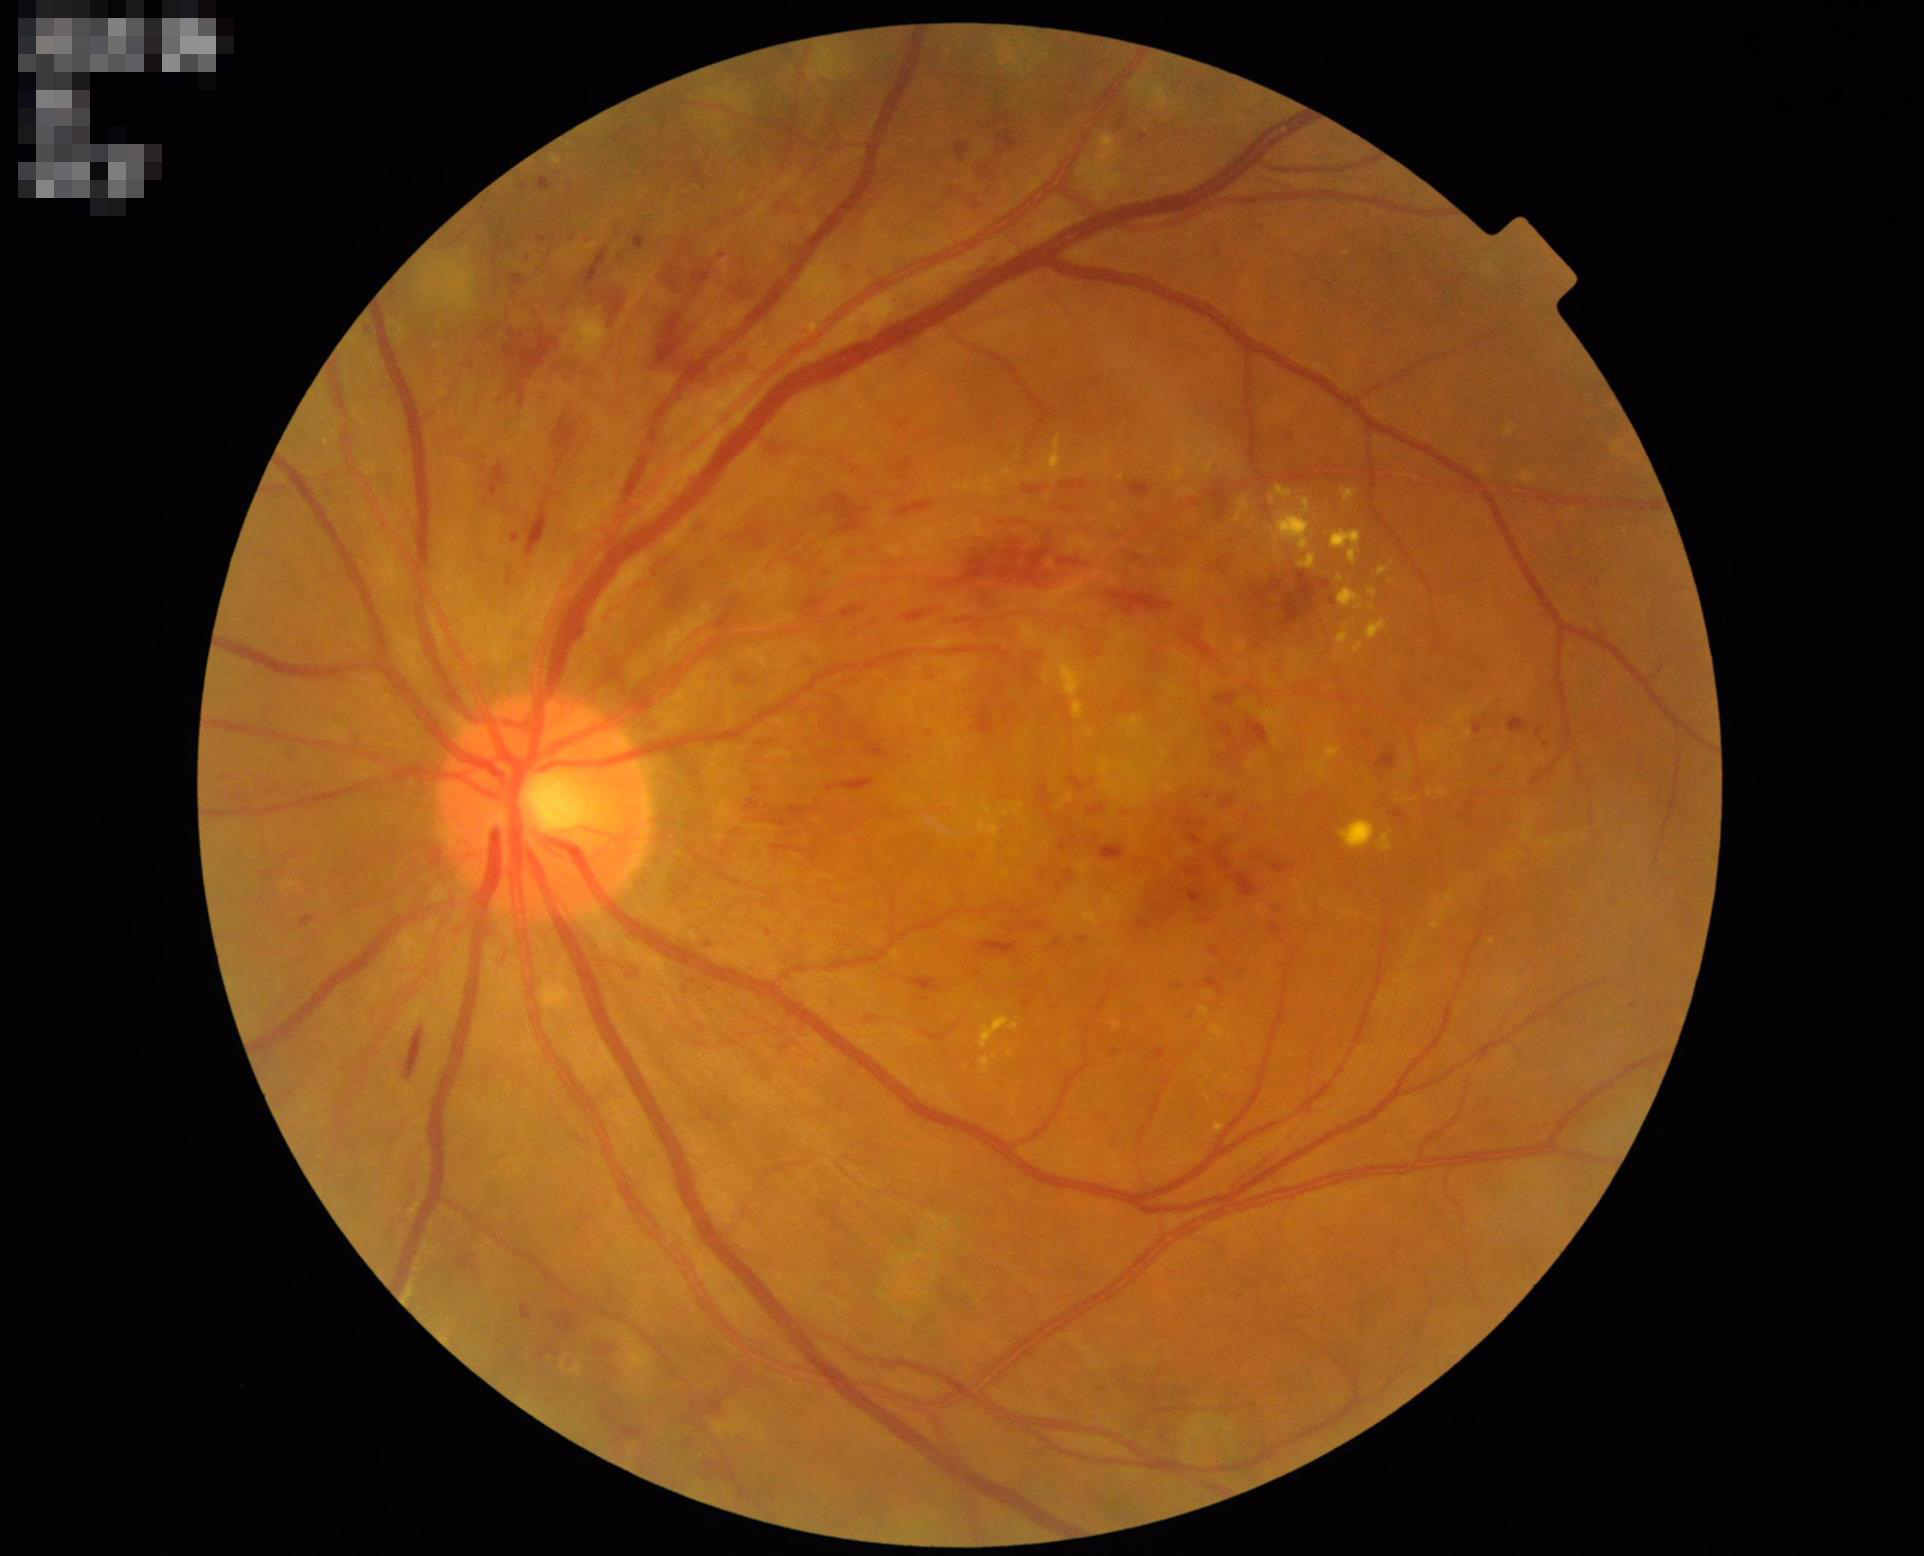

Contrast = good; Illumination/color = satisfactory; Overall quality = acceptable.